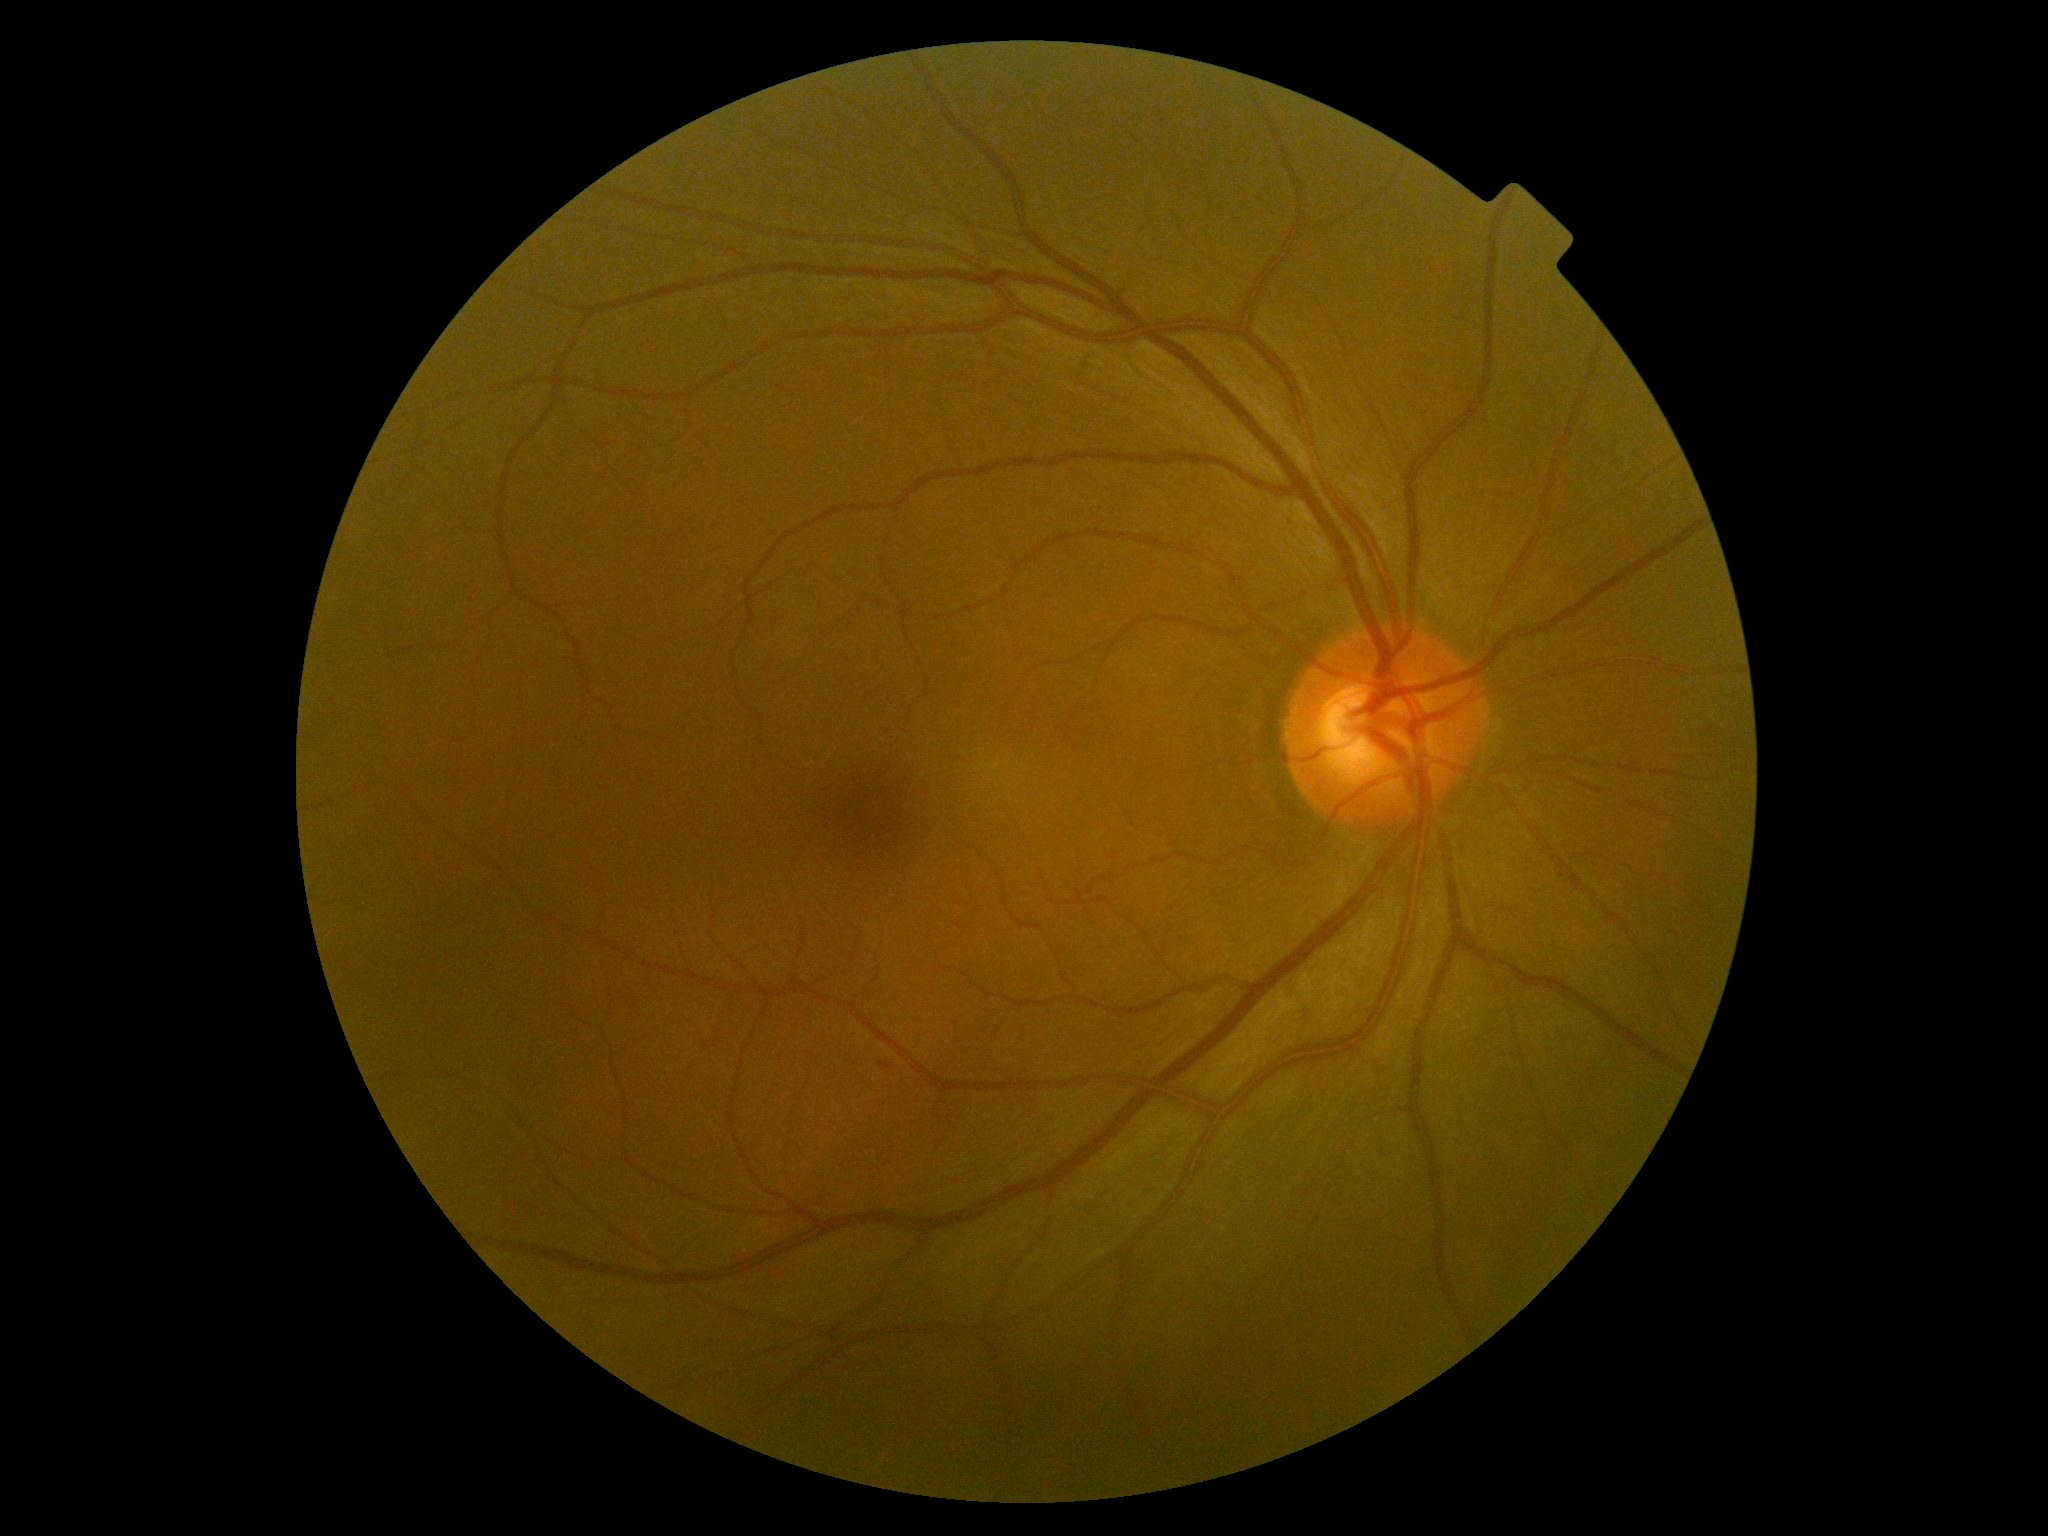 Annotations:
* DR class — non-proliferative diabetic retinopathy
* diabetic retinopathy (DR) — grade 1